Wide-field fundus photograph of an infant
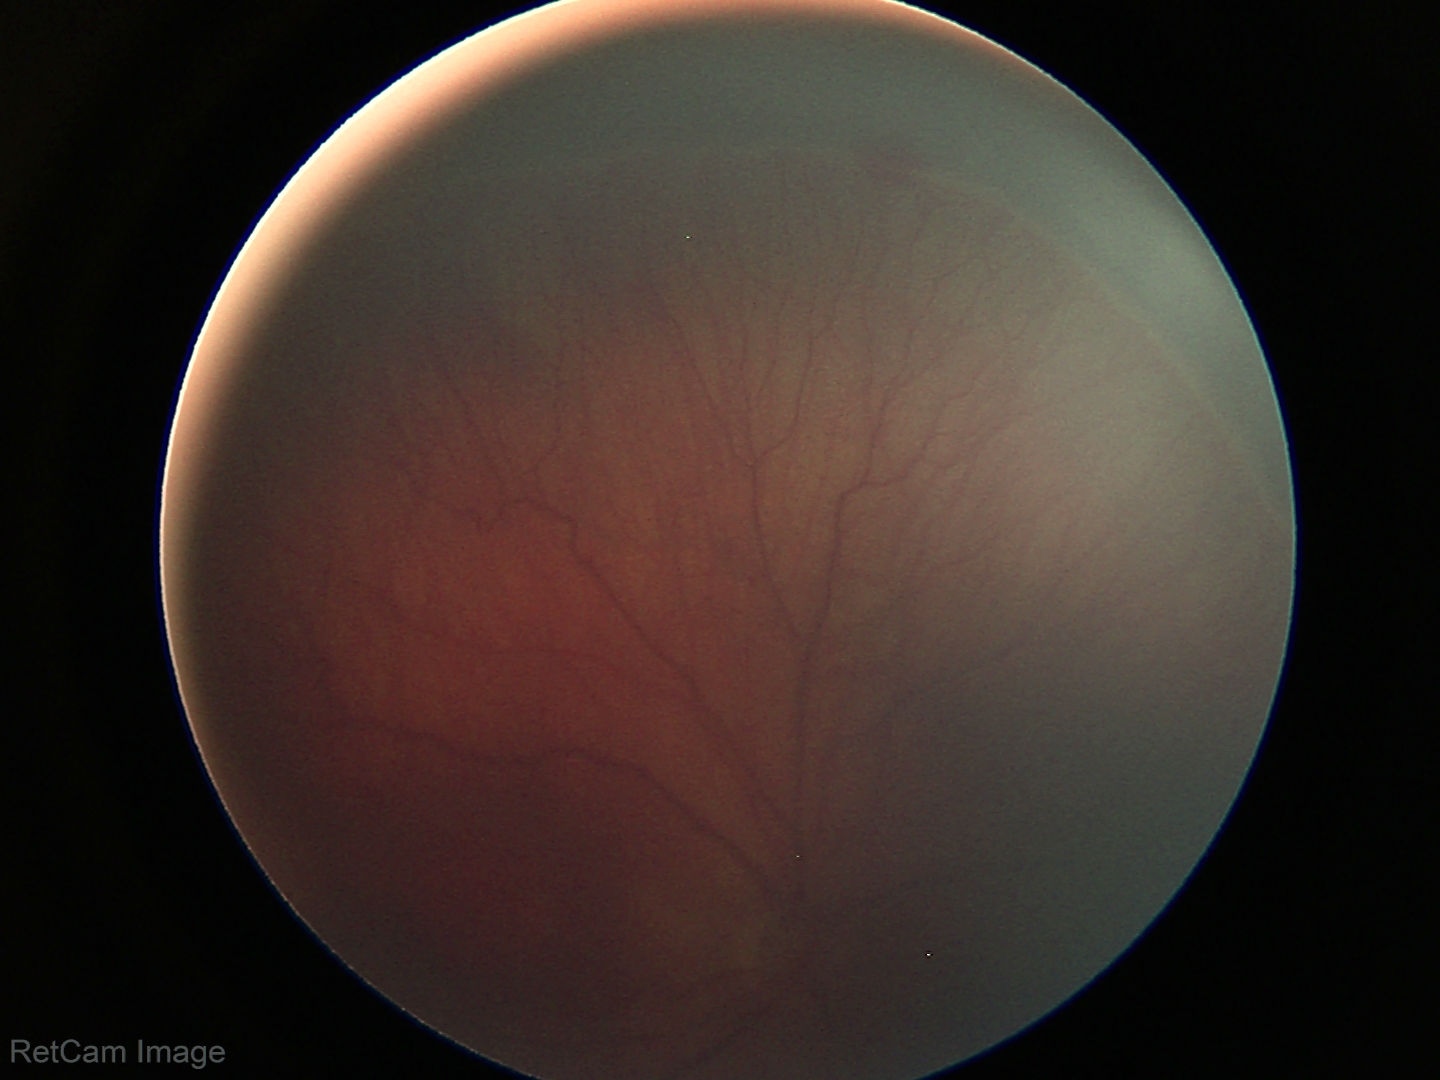 Diagnosis from this screening exam: retinopathy of prematurity stage 3.